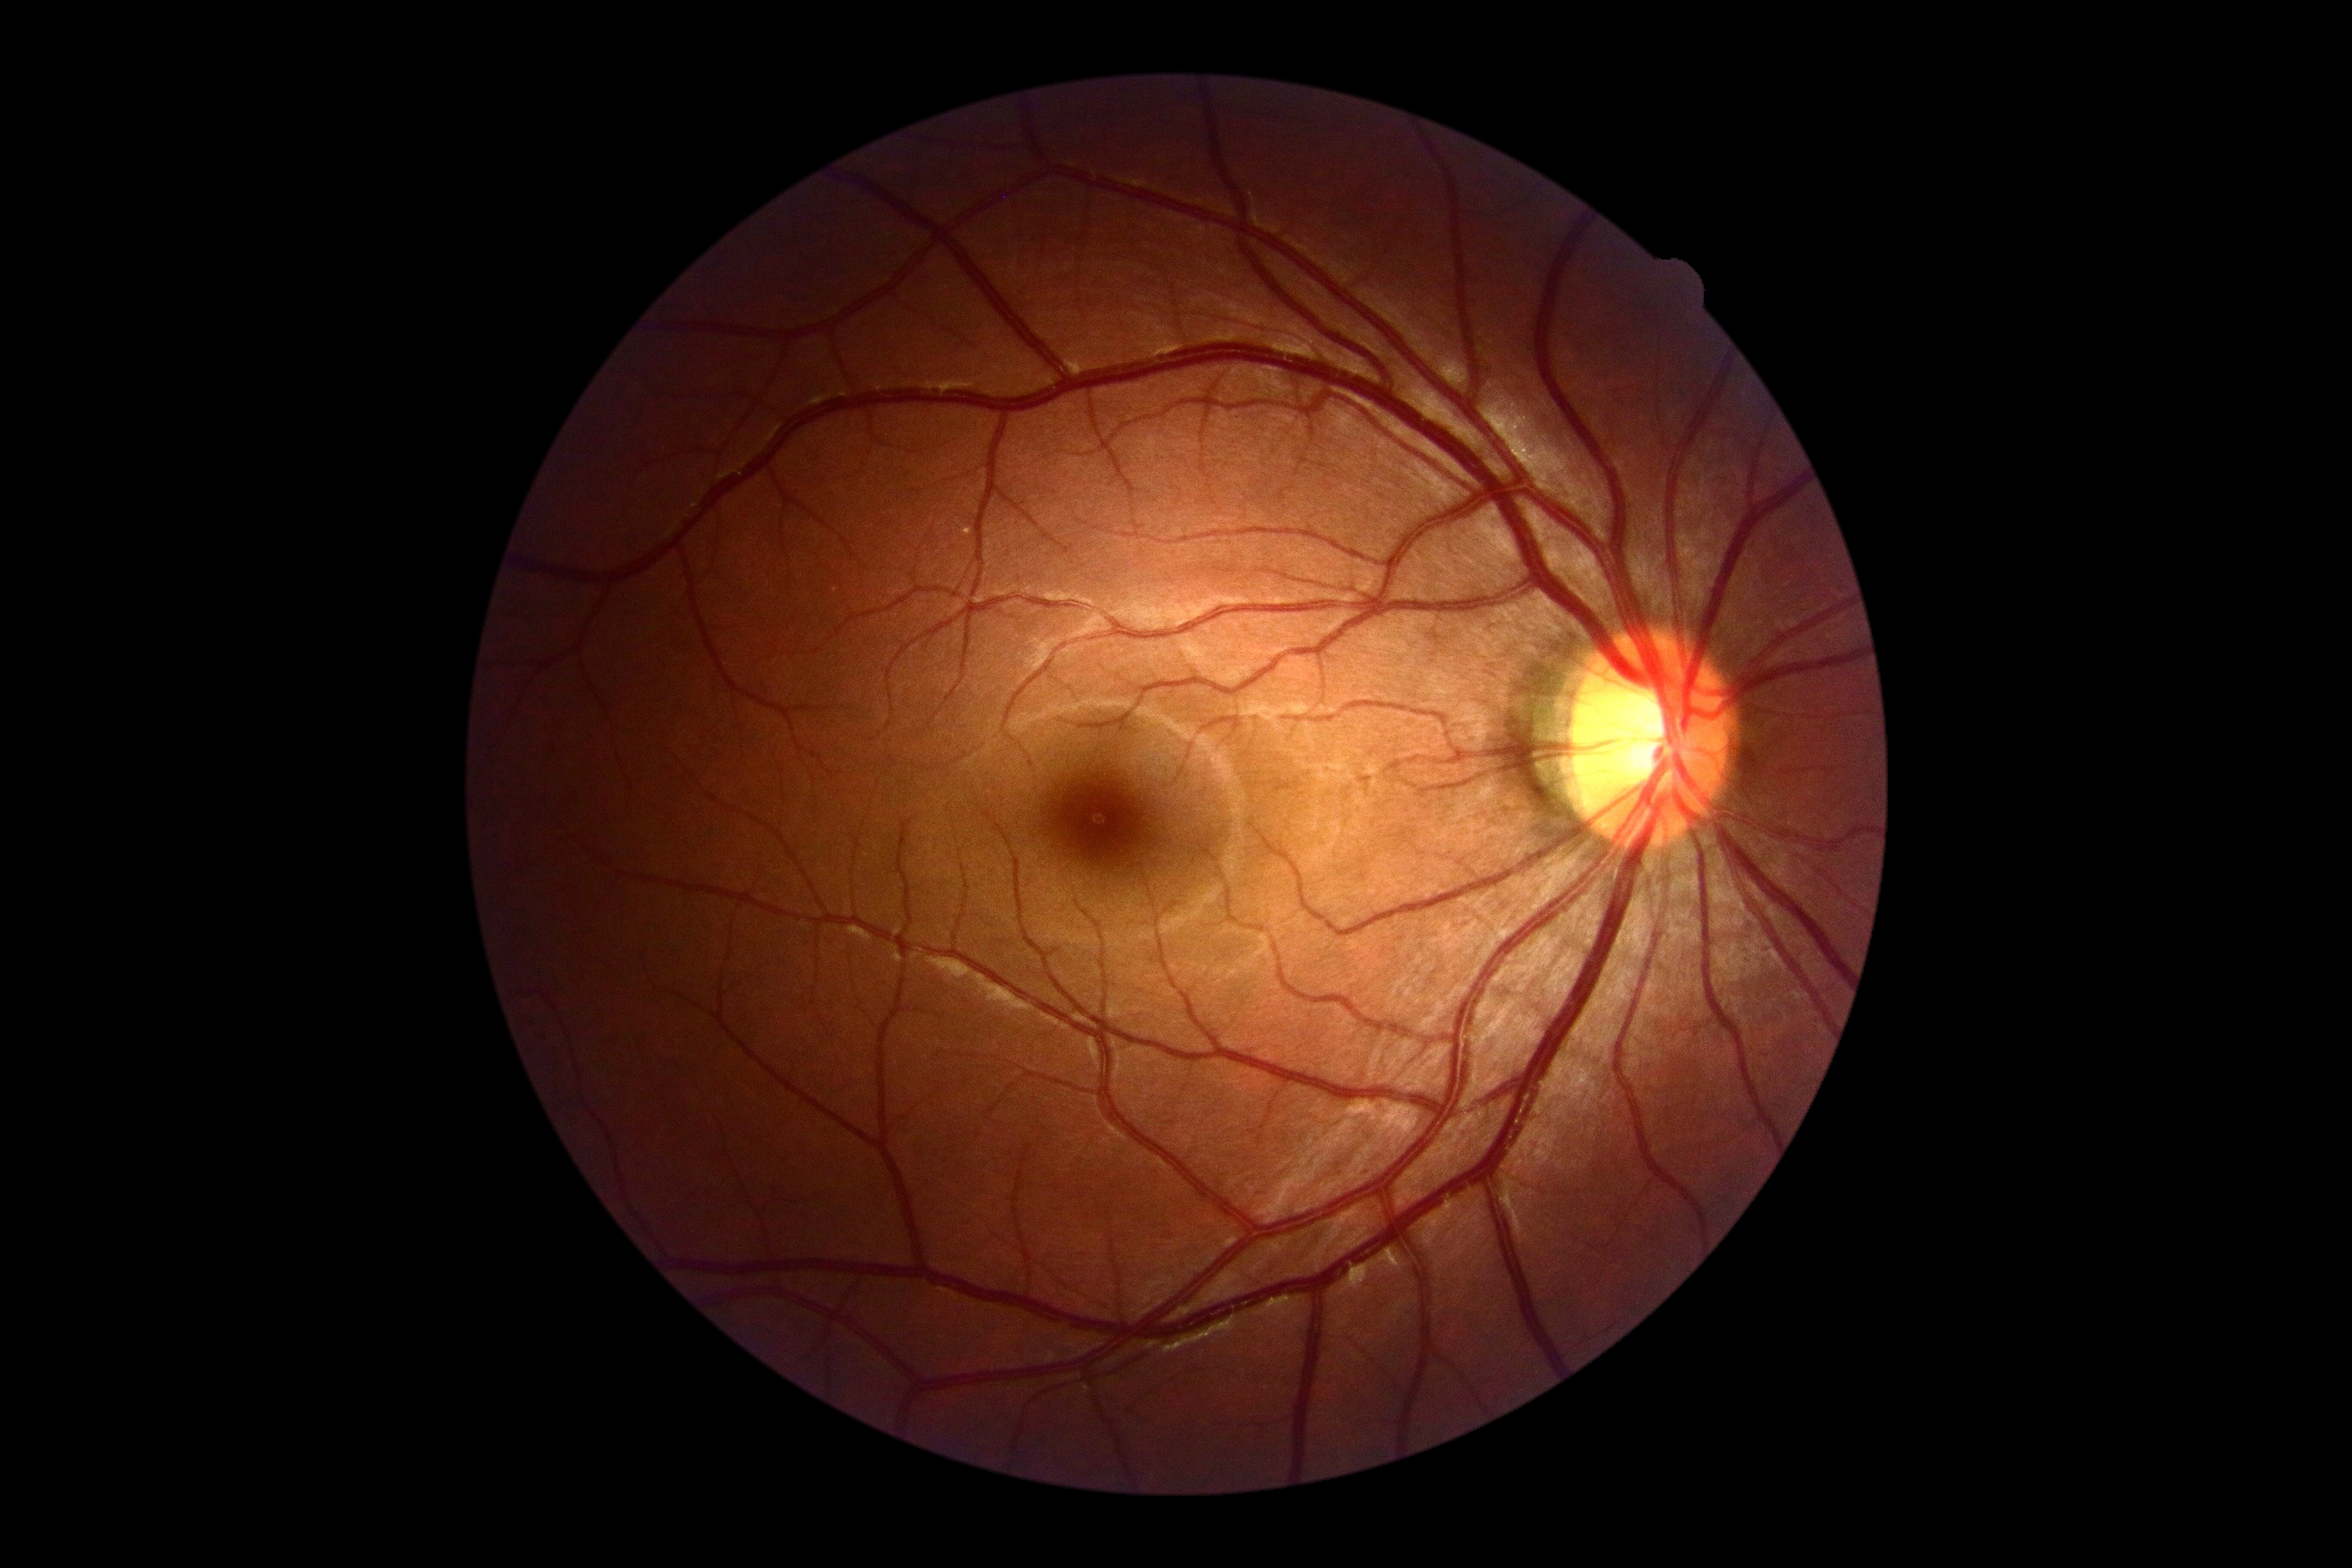
dr_grade: 0 (no apparent retinopathy)